Diabetic retinopathy graded by the modified Davis classification:
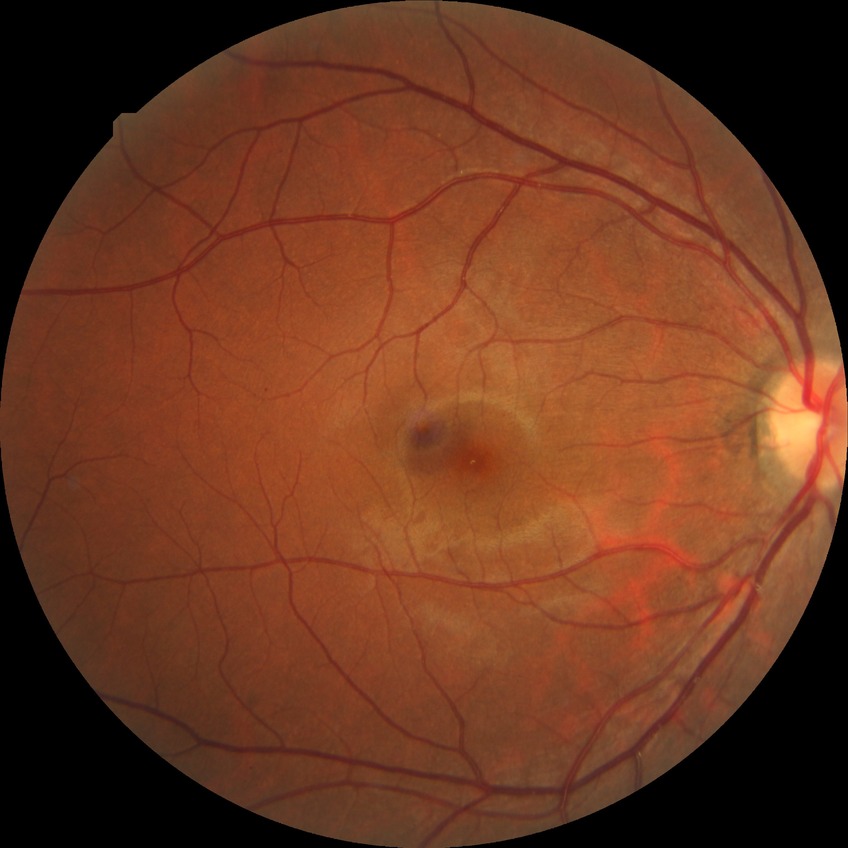 DR grade is SDR.